Pediatric wide-field fundus photograph. Image size 640x480: 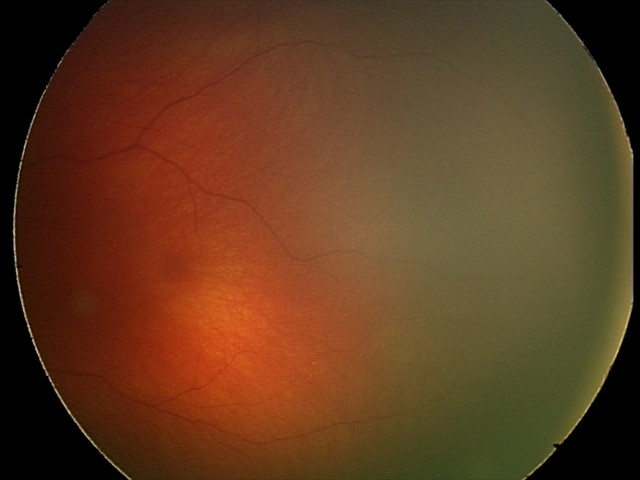

Normal screening examination.